2212x1659px — 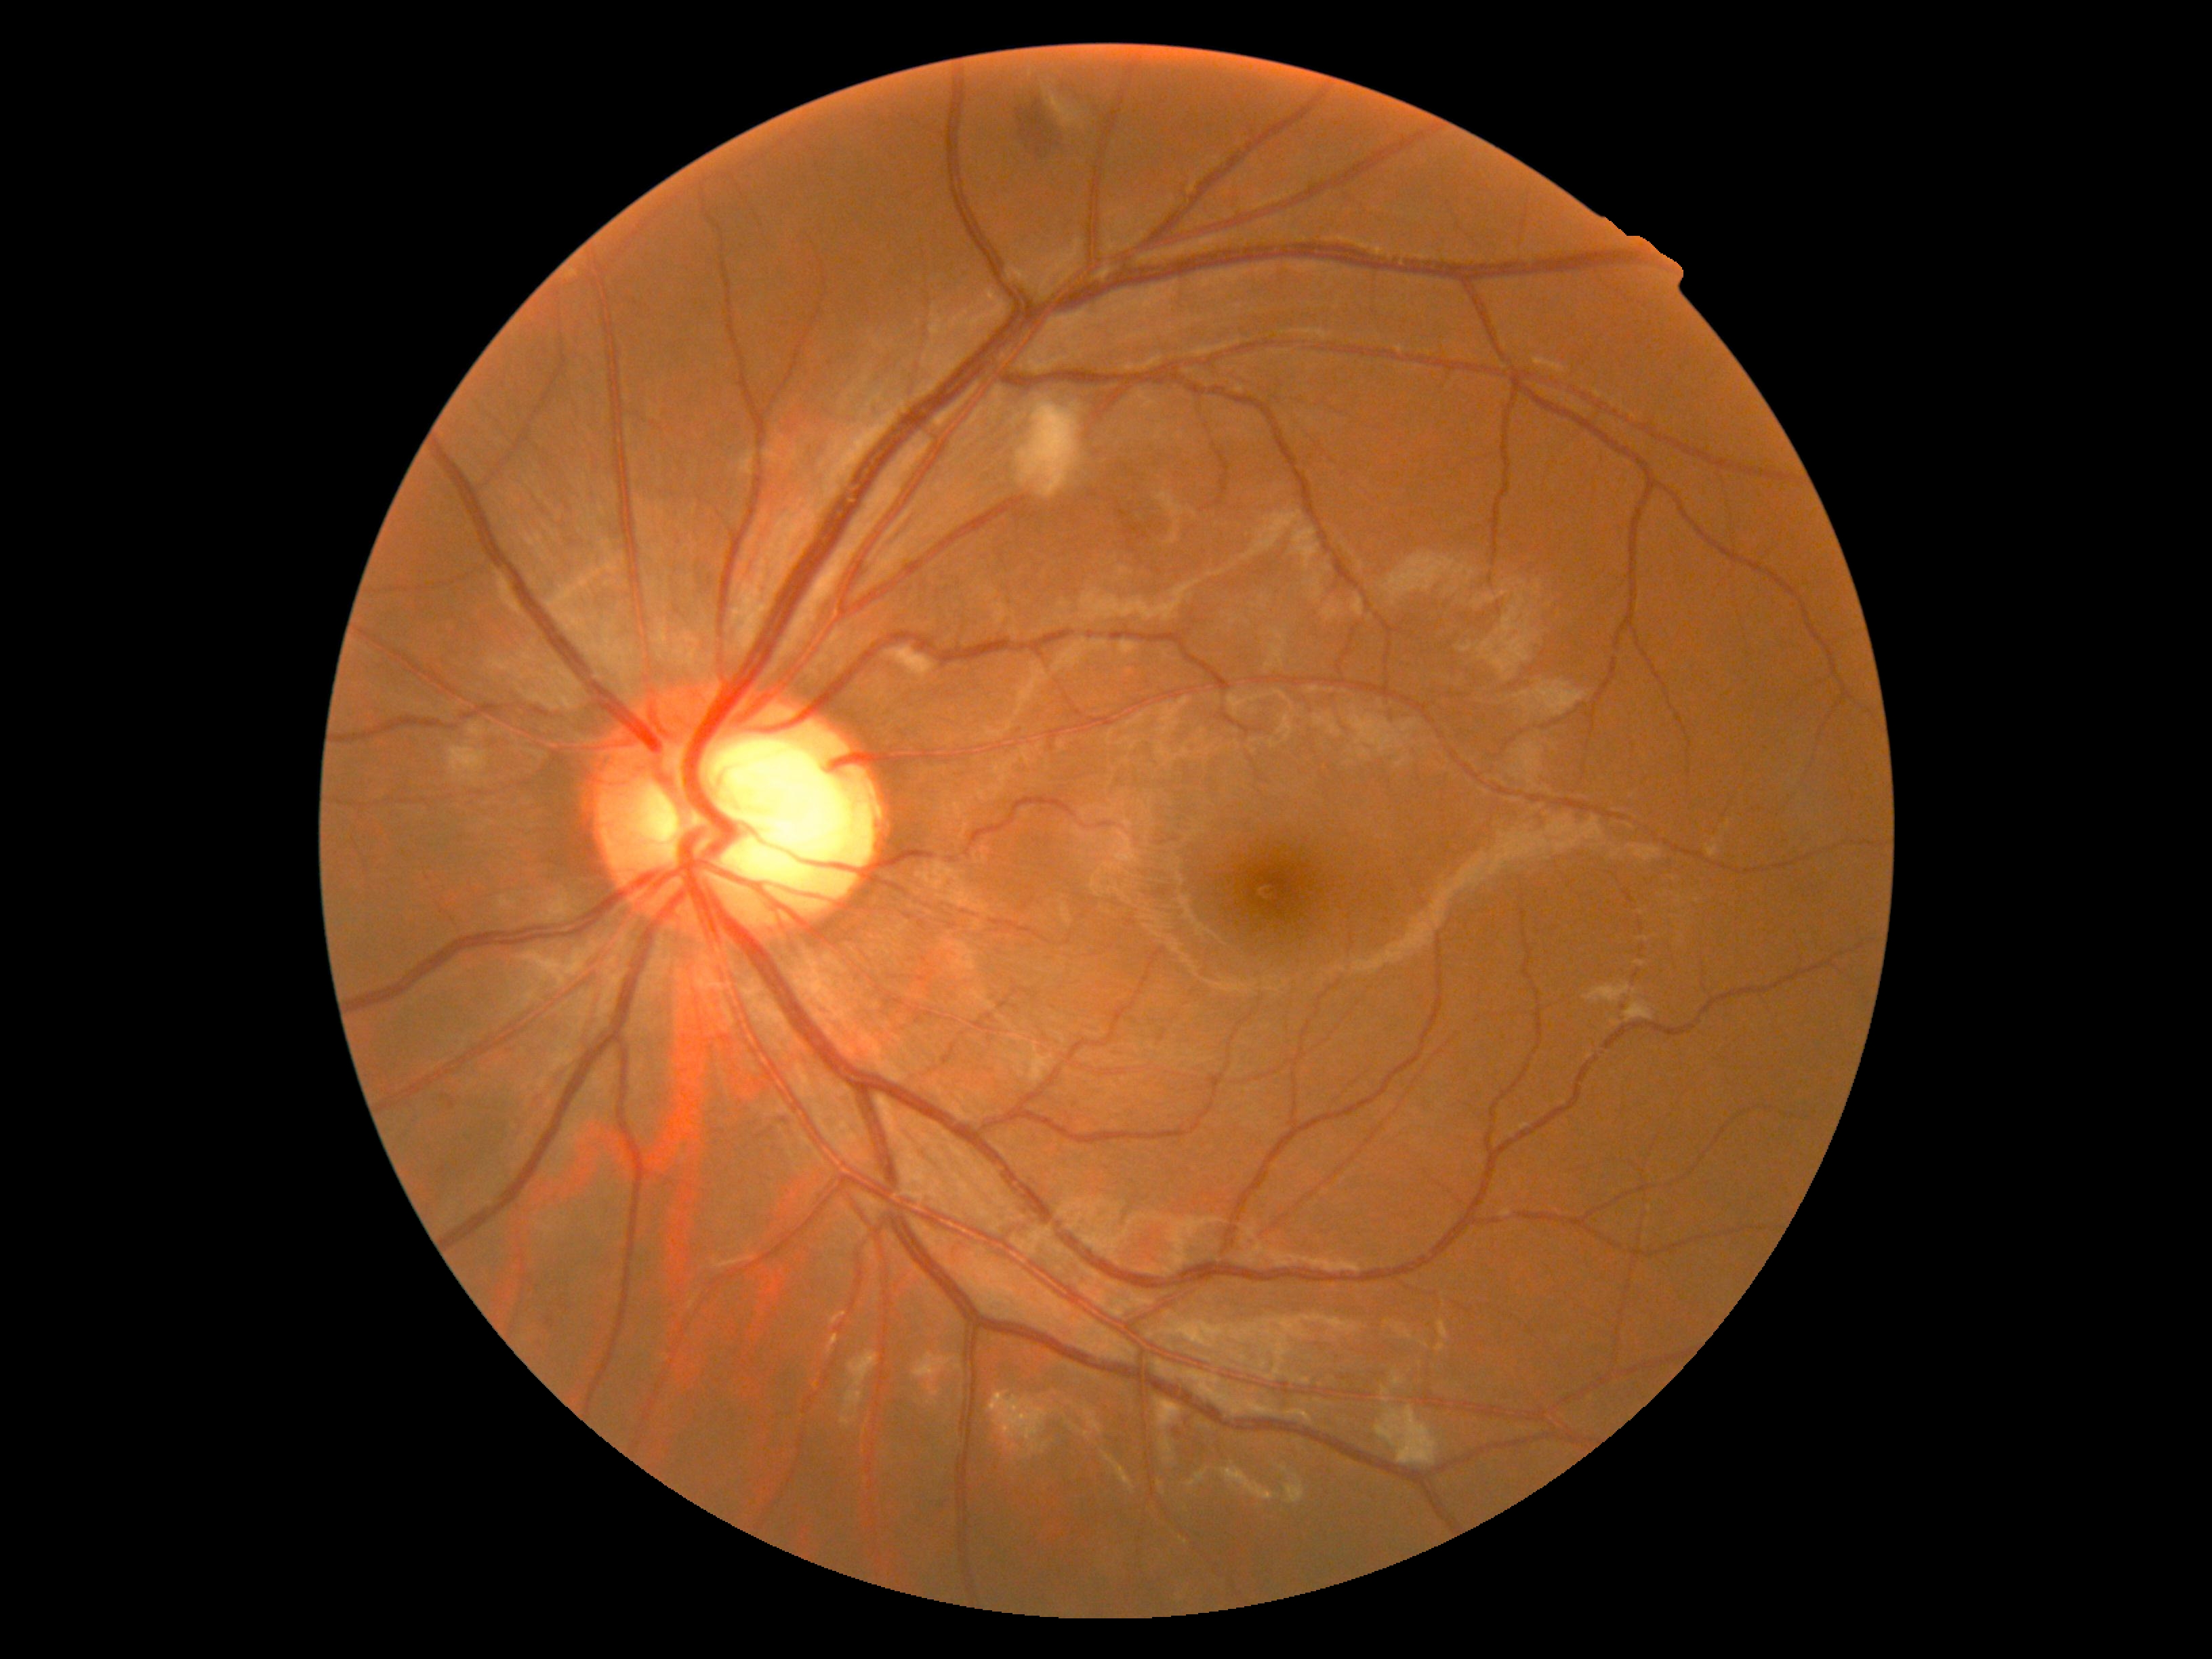 dr_grade: 2
lesions:
  ma: []
  se:
    - 1048, 96, 1082, 128
    - 1017, 401, 1082, 499
    - 884, 647, 936, 685
    - 448, 742, 489, 785
    - 468, 723, 486, 738
  he:
    - 1176, 1417, 1197, 1444
    - 1010, 89, 1066, 158
    - 448, 1101, 456, 1111
  ex: []